1240x1240. Acquired on the Phoenix ICON. Infant wide-field fundus photograph.
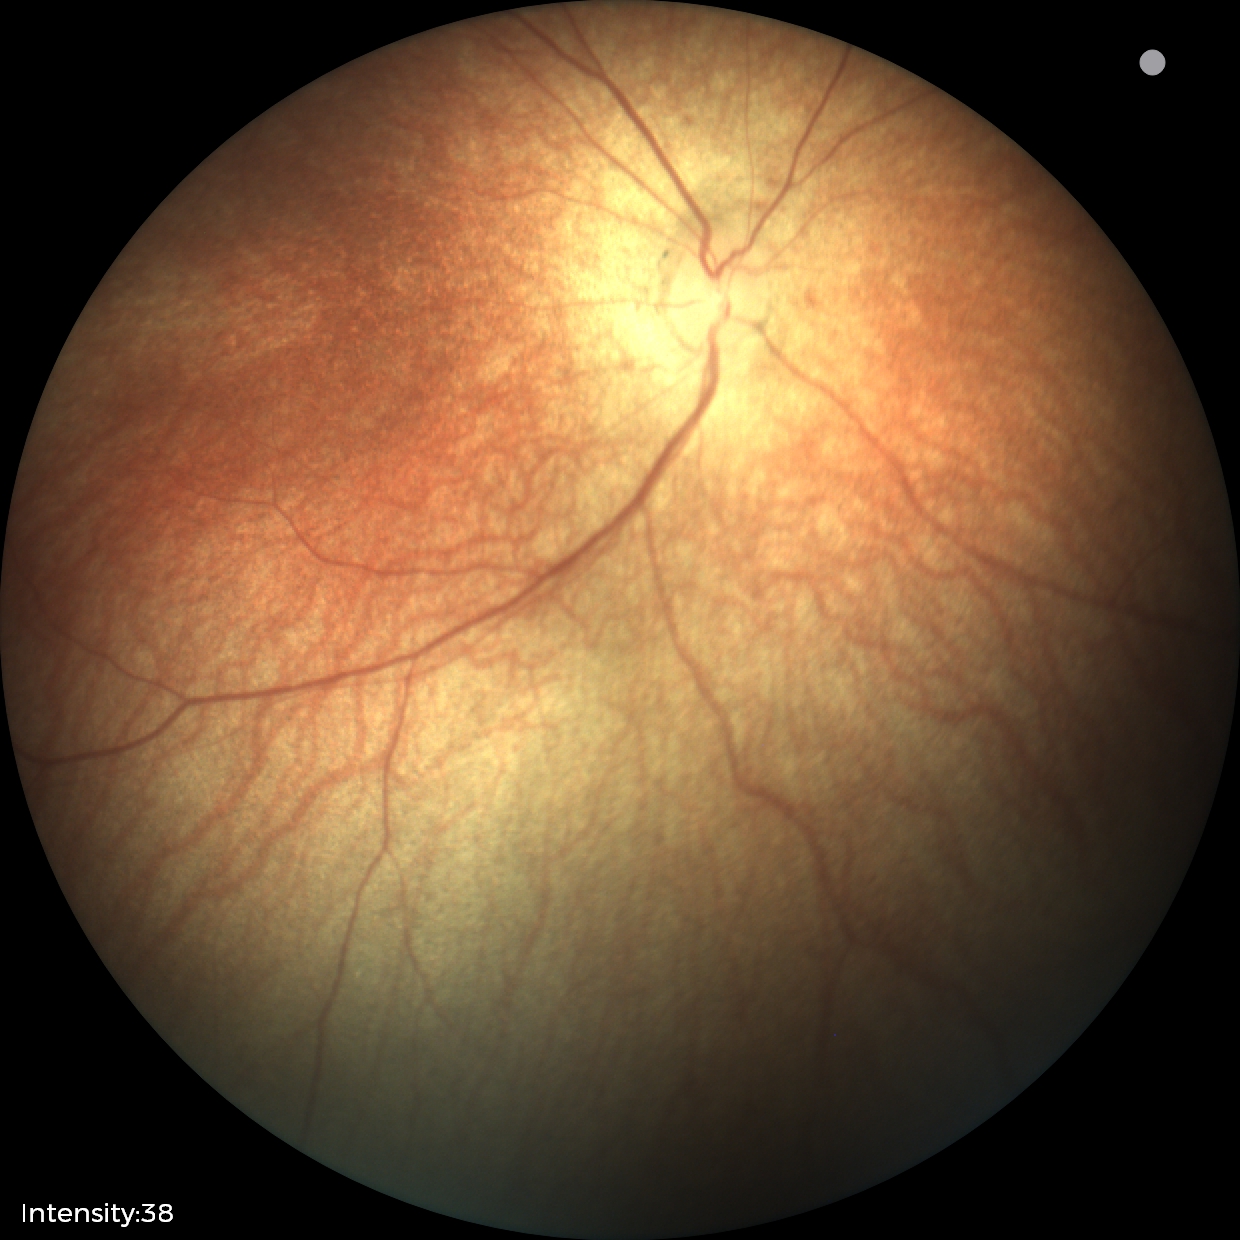
Screening examination with no abnormal retinal findings.